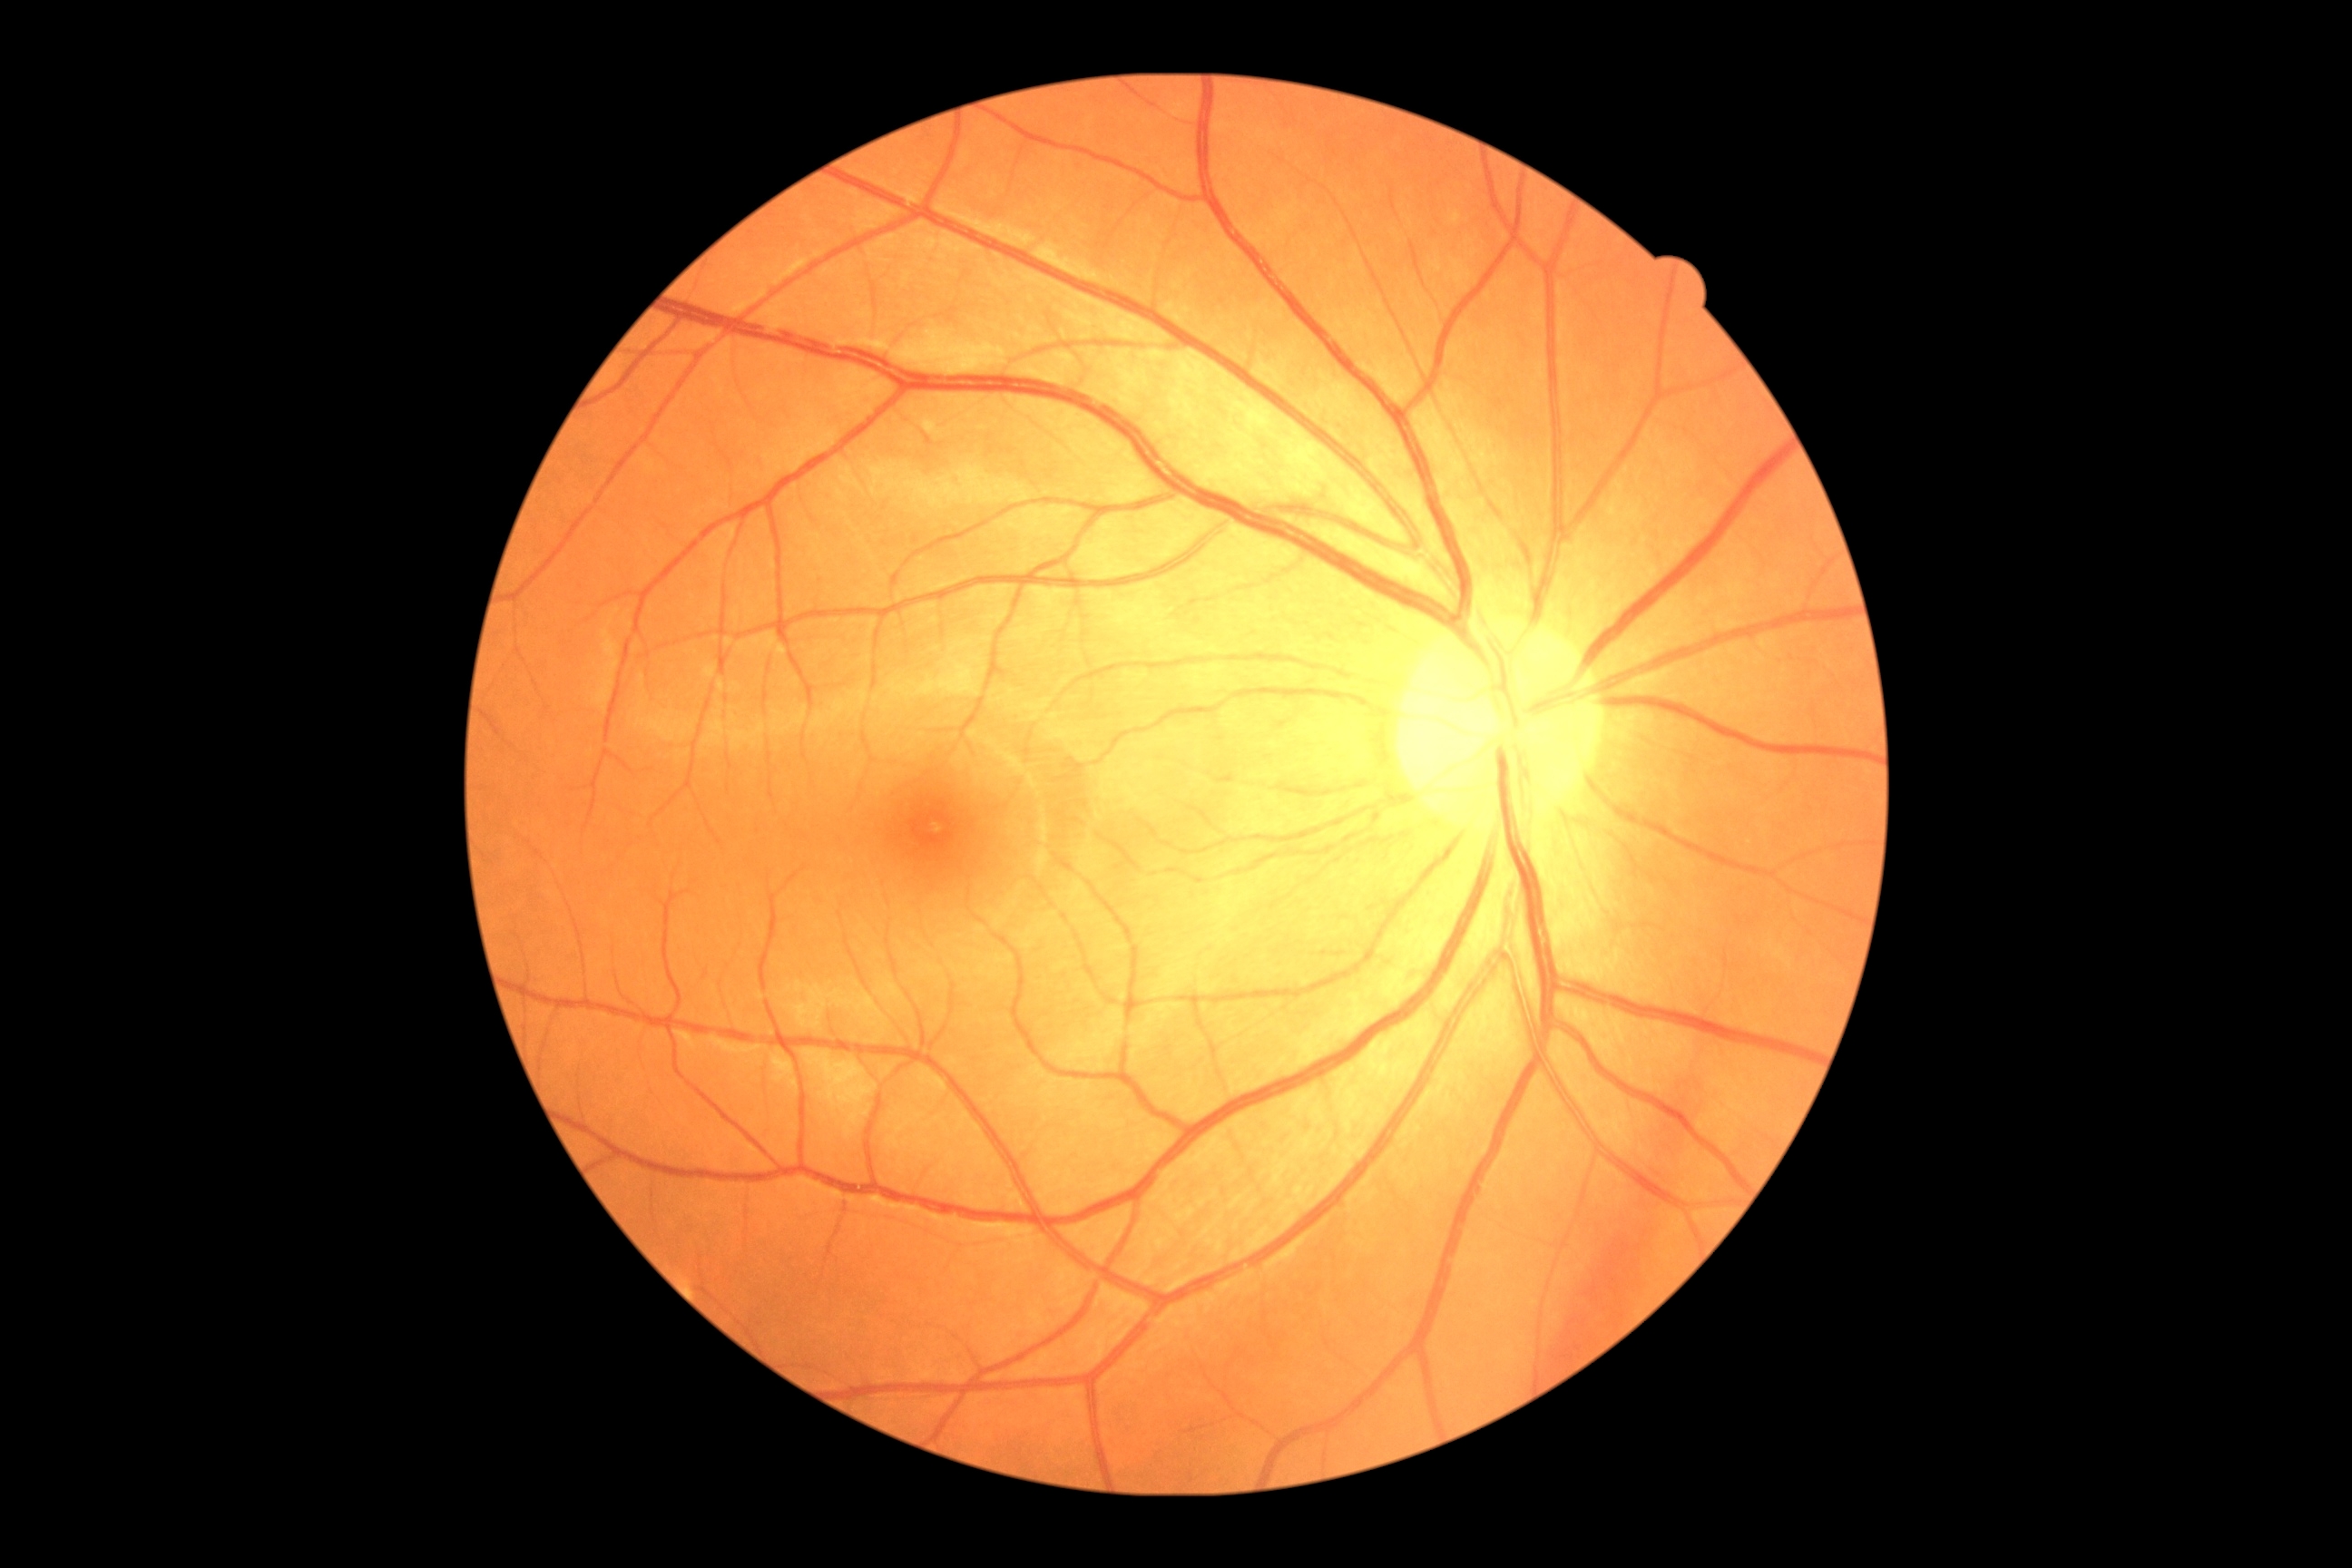 DR grade: 0 (no apparent retinopathy), DR impression: no apparent DR.